Posterior pole photograph. Image size 848x848. Camera: NIDEK AFC-230. Without pupil dilation. 45-degree field of view
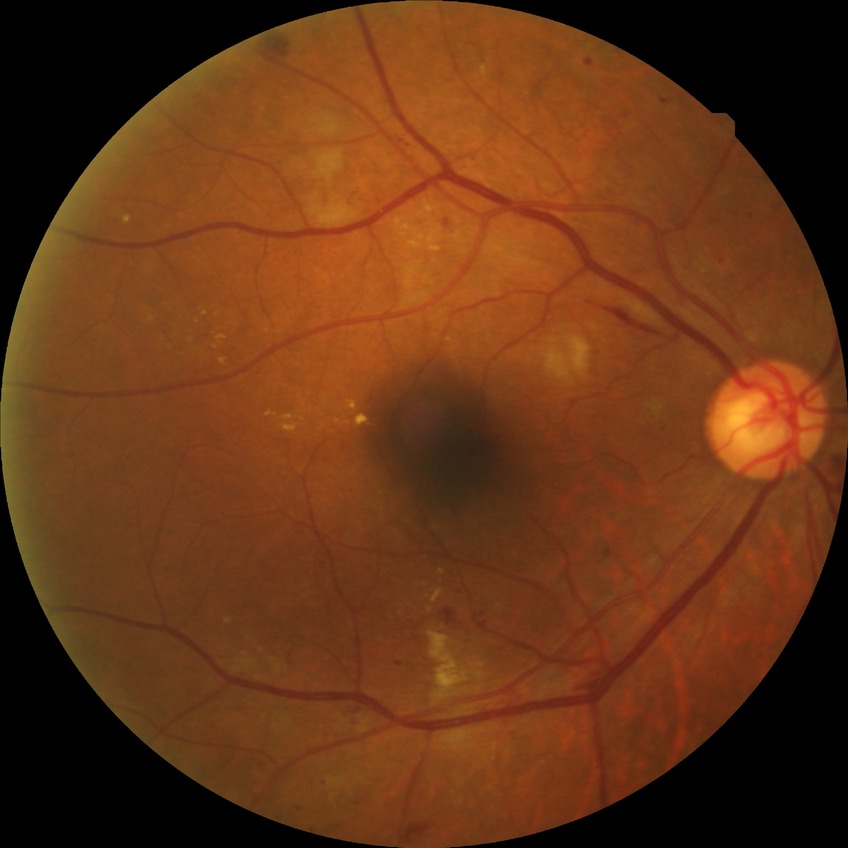
Diabetic retinopathy (DR): pre-proliferative diabetic retinopathy (PPDR).